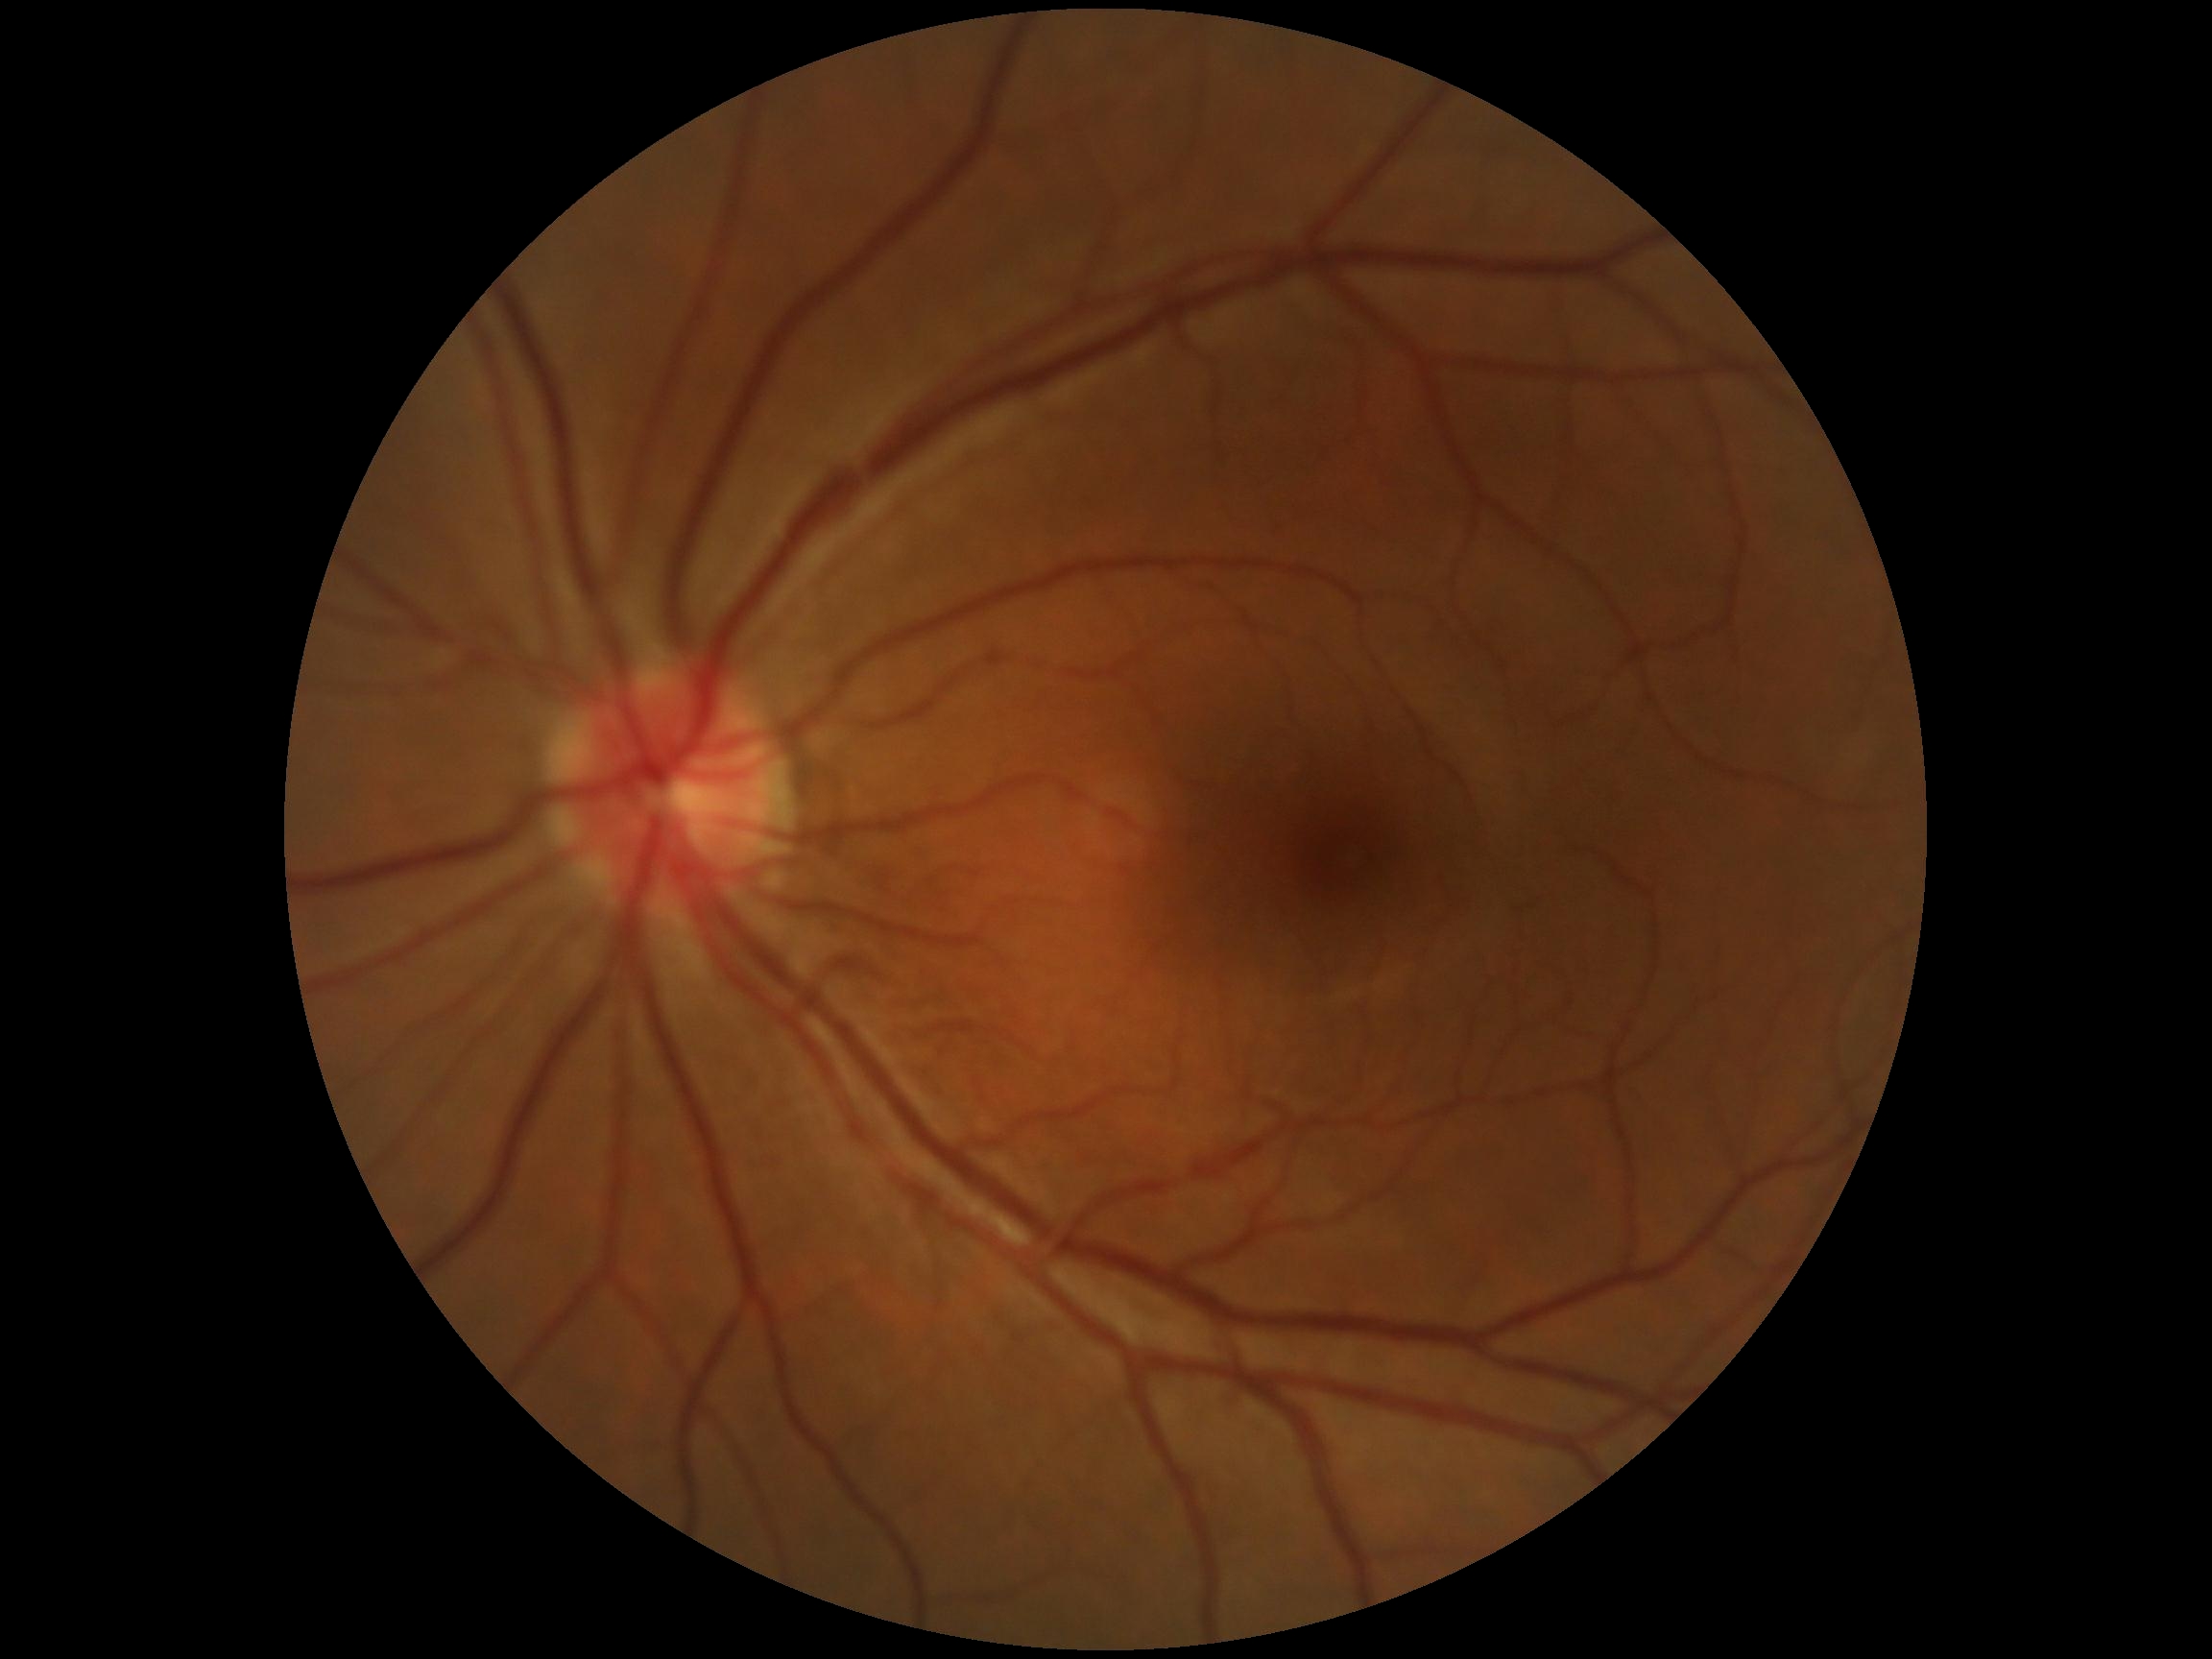 DR stage is grade 0 (no apparent retinopathy).